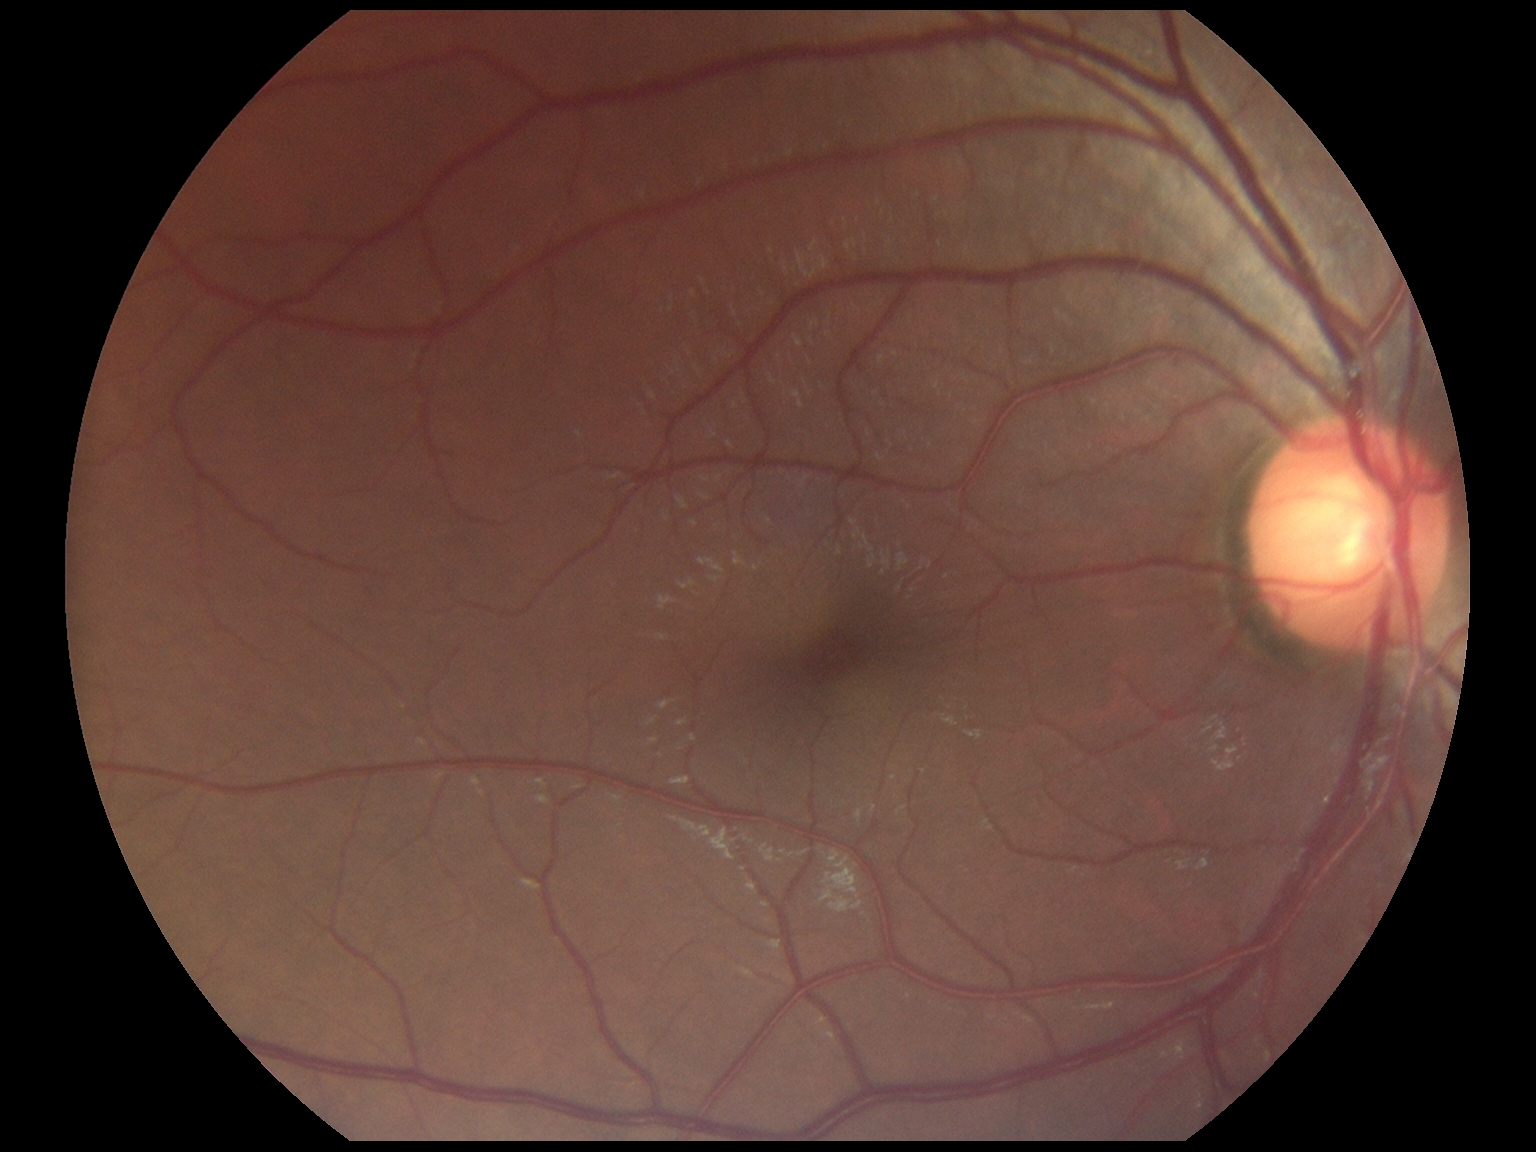 No diabetic retinal disease findings.
Diabetic retinopathy (DR) is no apparent retinopathy (grade 0) — no visible signs of diabetic retinopathy.